1932x1916: 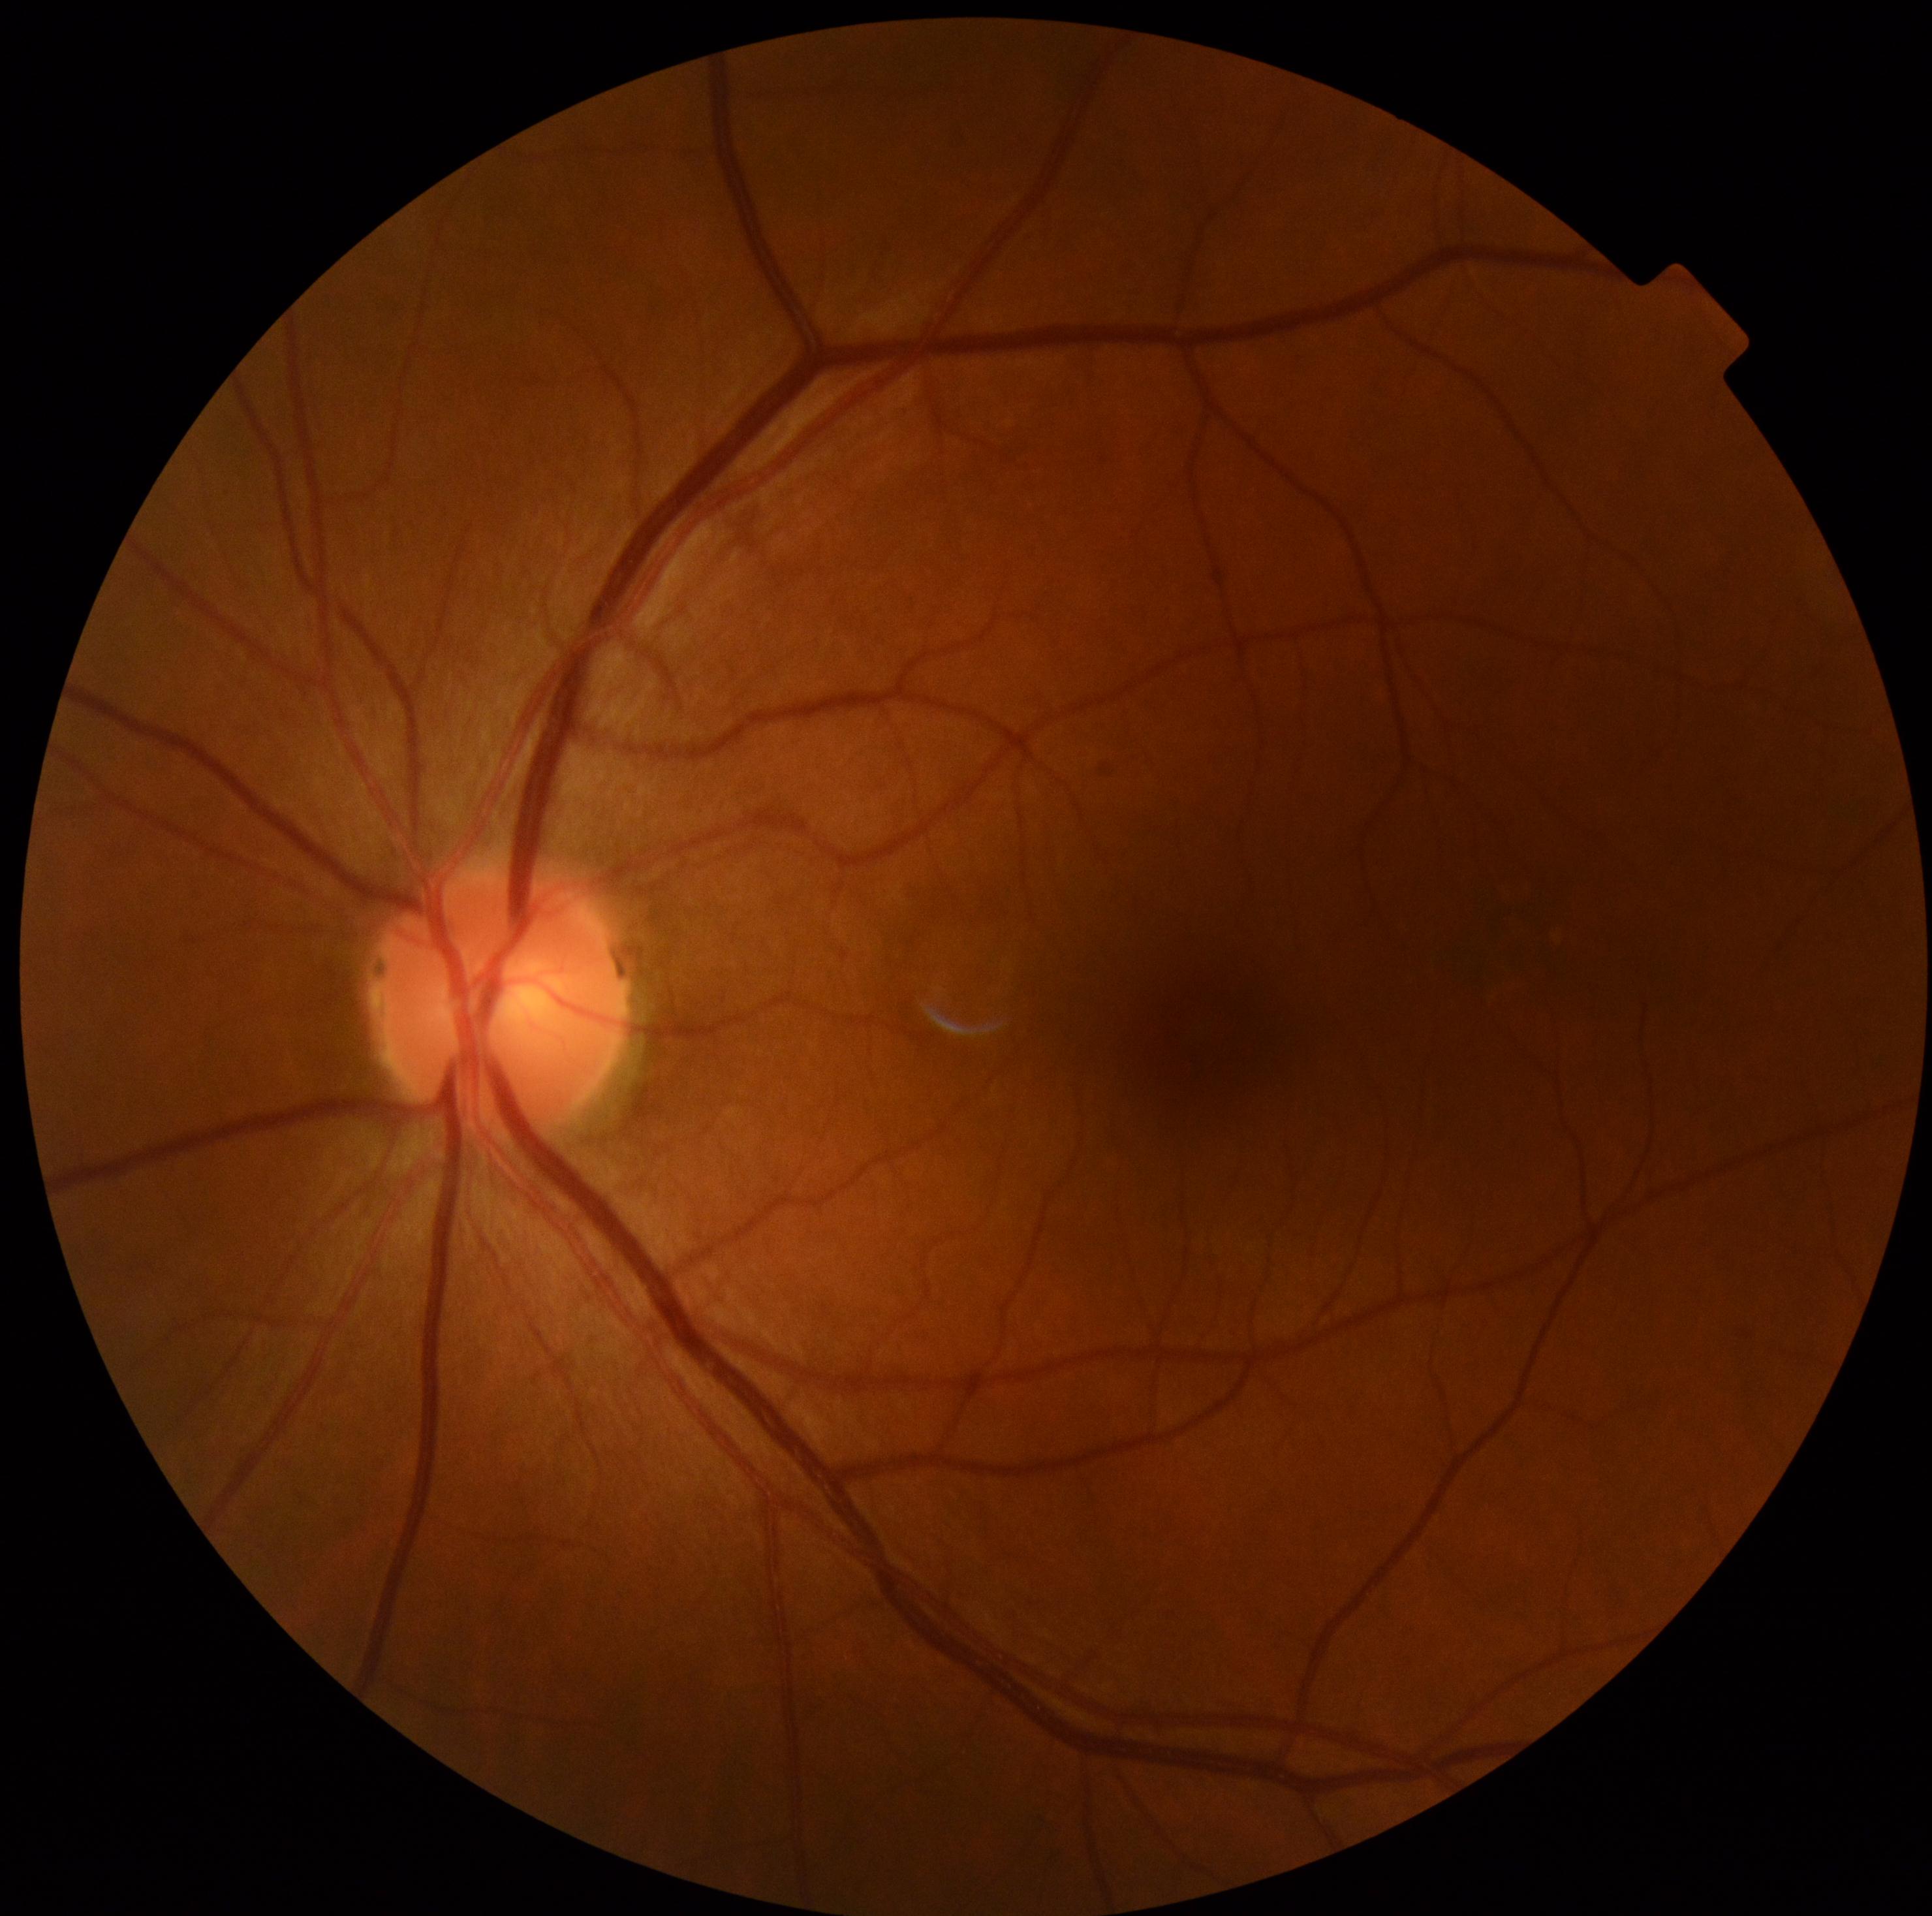
  dr_grade: no apparent diabetic retinopathy (grade 0)